Posterior pole photograph.
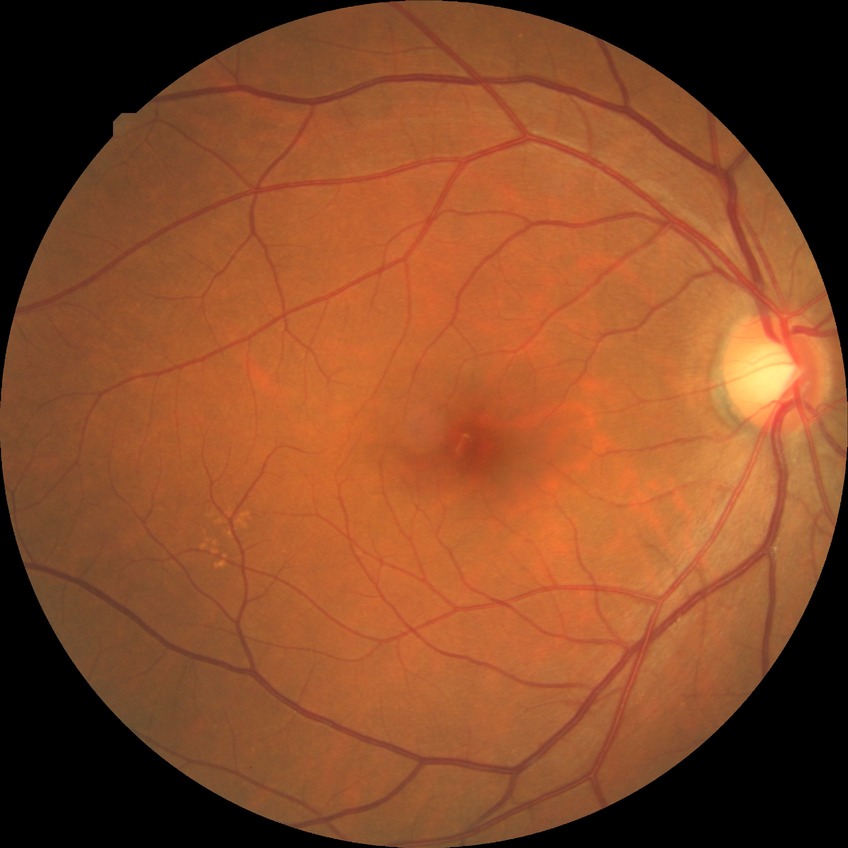
diabetic retinopathy (DR): NDR (no diabetic retinopathy)